Wide-field contact fundus photograph of an infant; camera: Natus RetCam Envision (130° FOV)
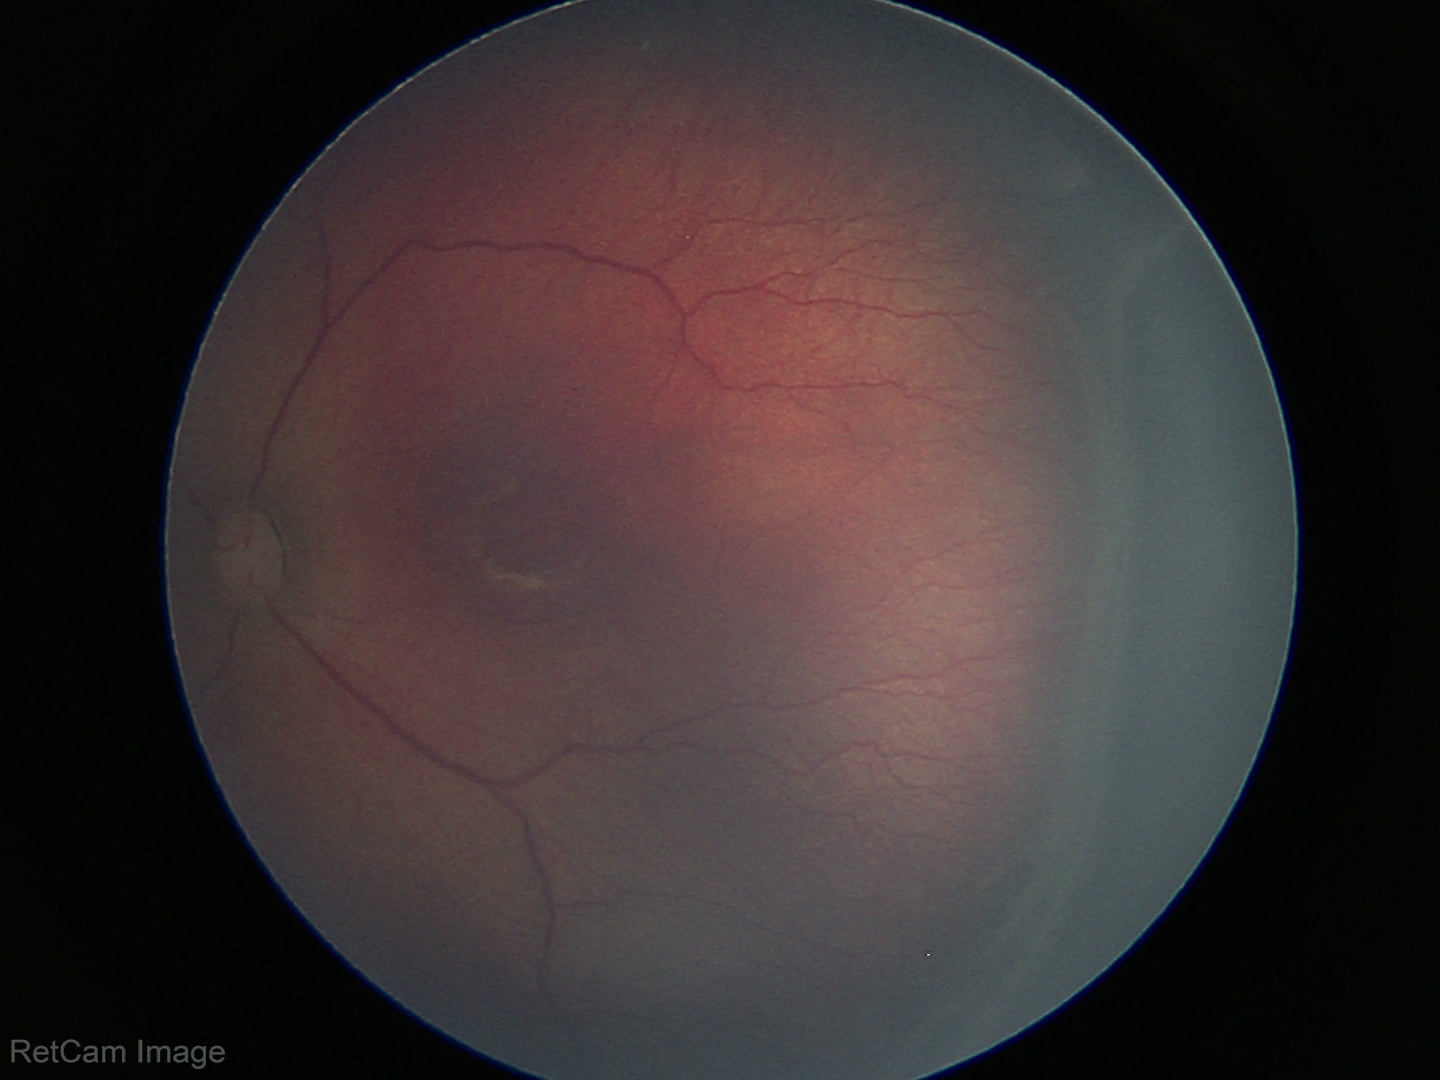
Screening diagnosis: retinopathy of prematurity (ROP) stage 3 — ridge with extraretinal fibrovascular proliferation